45-degree field of view:
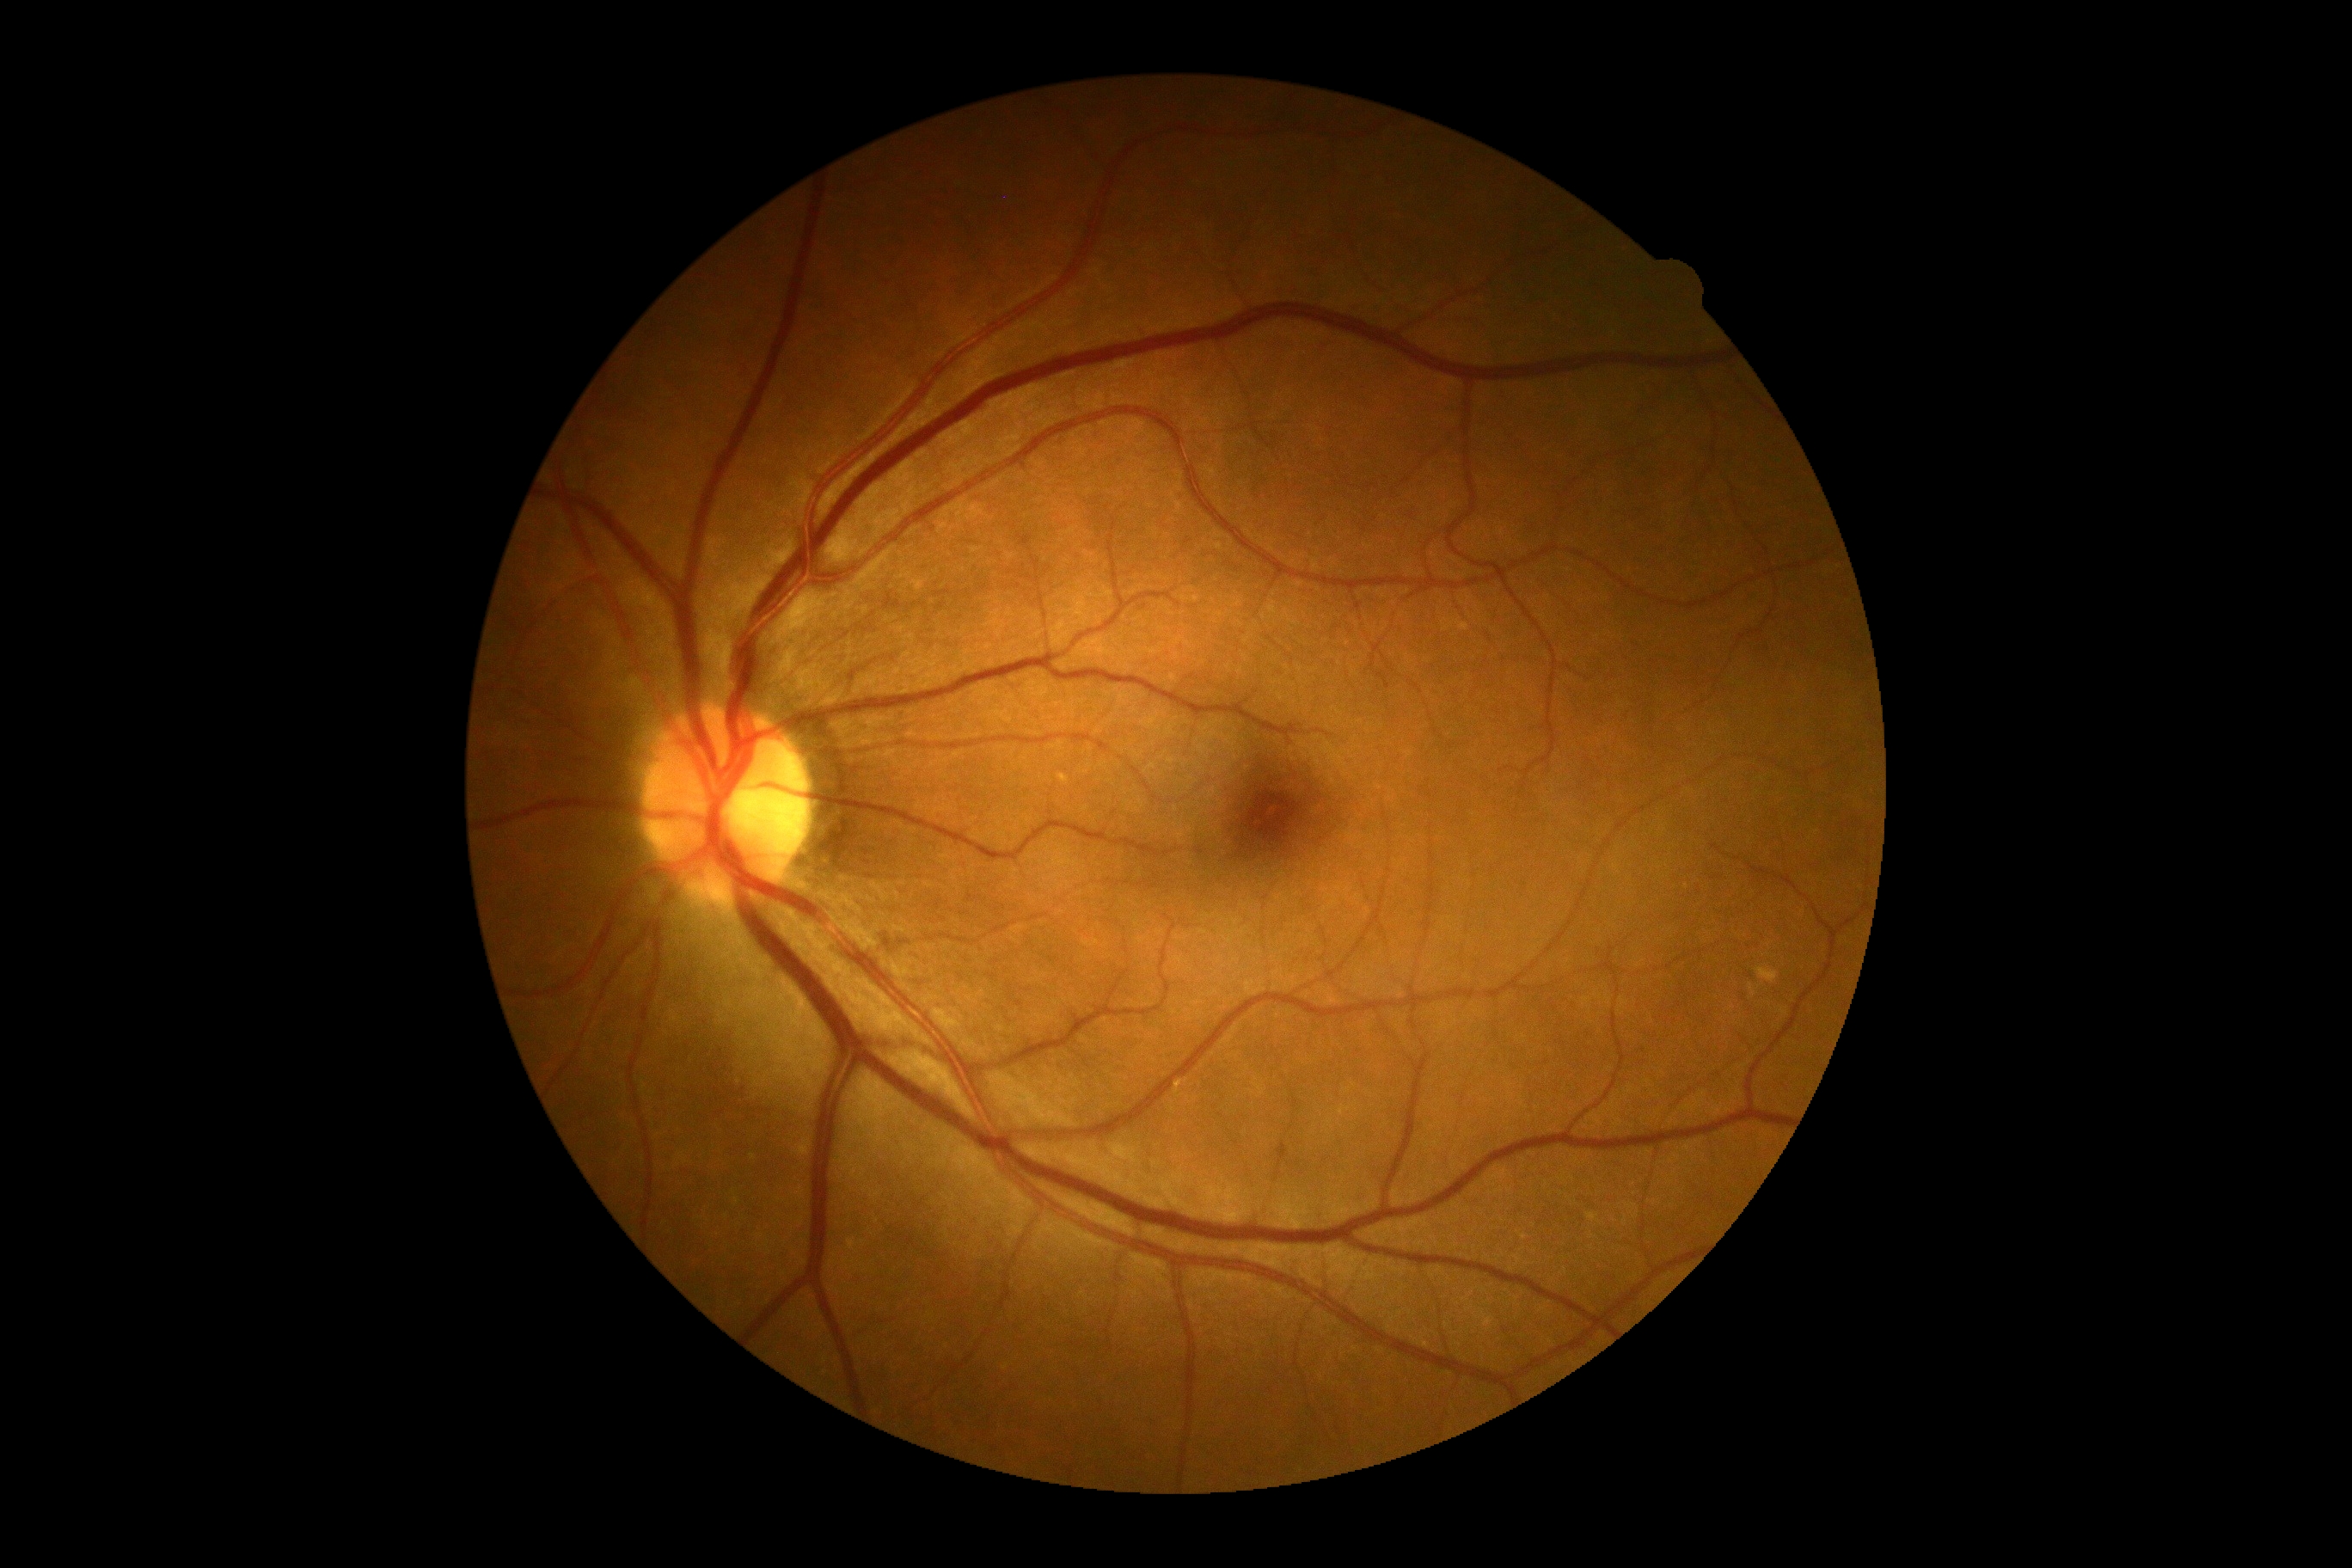
diabetic retinopathy (DR) = no apparent diabetic retinopathy (grade 0).